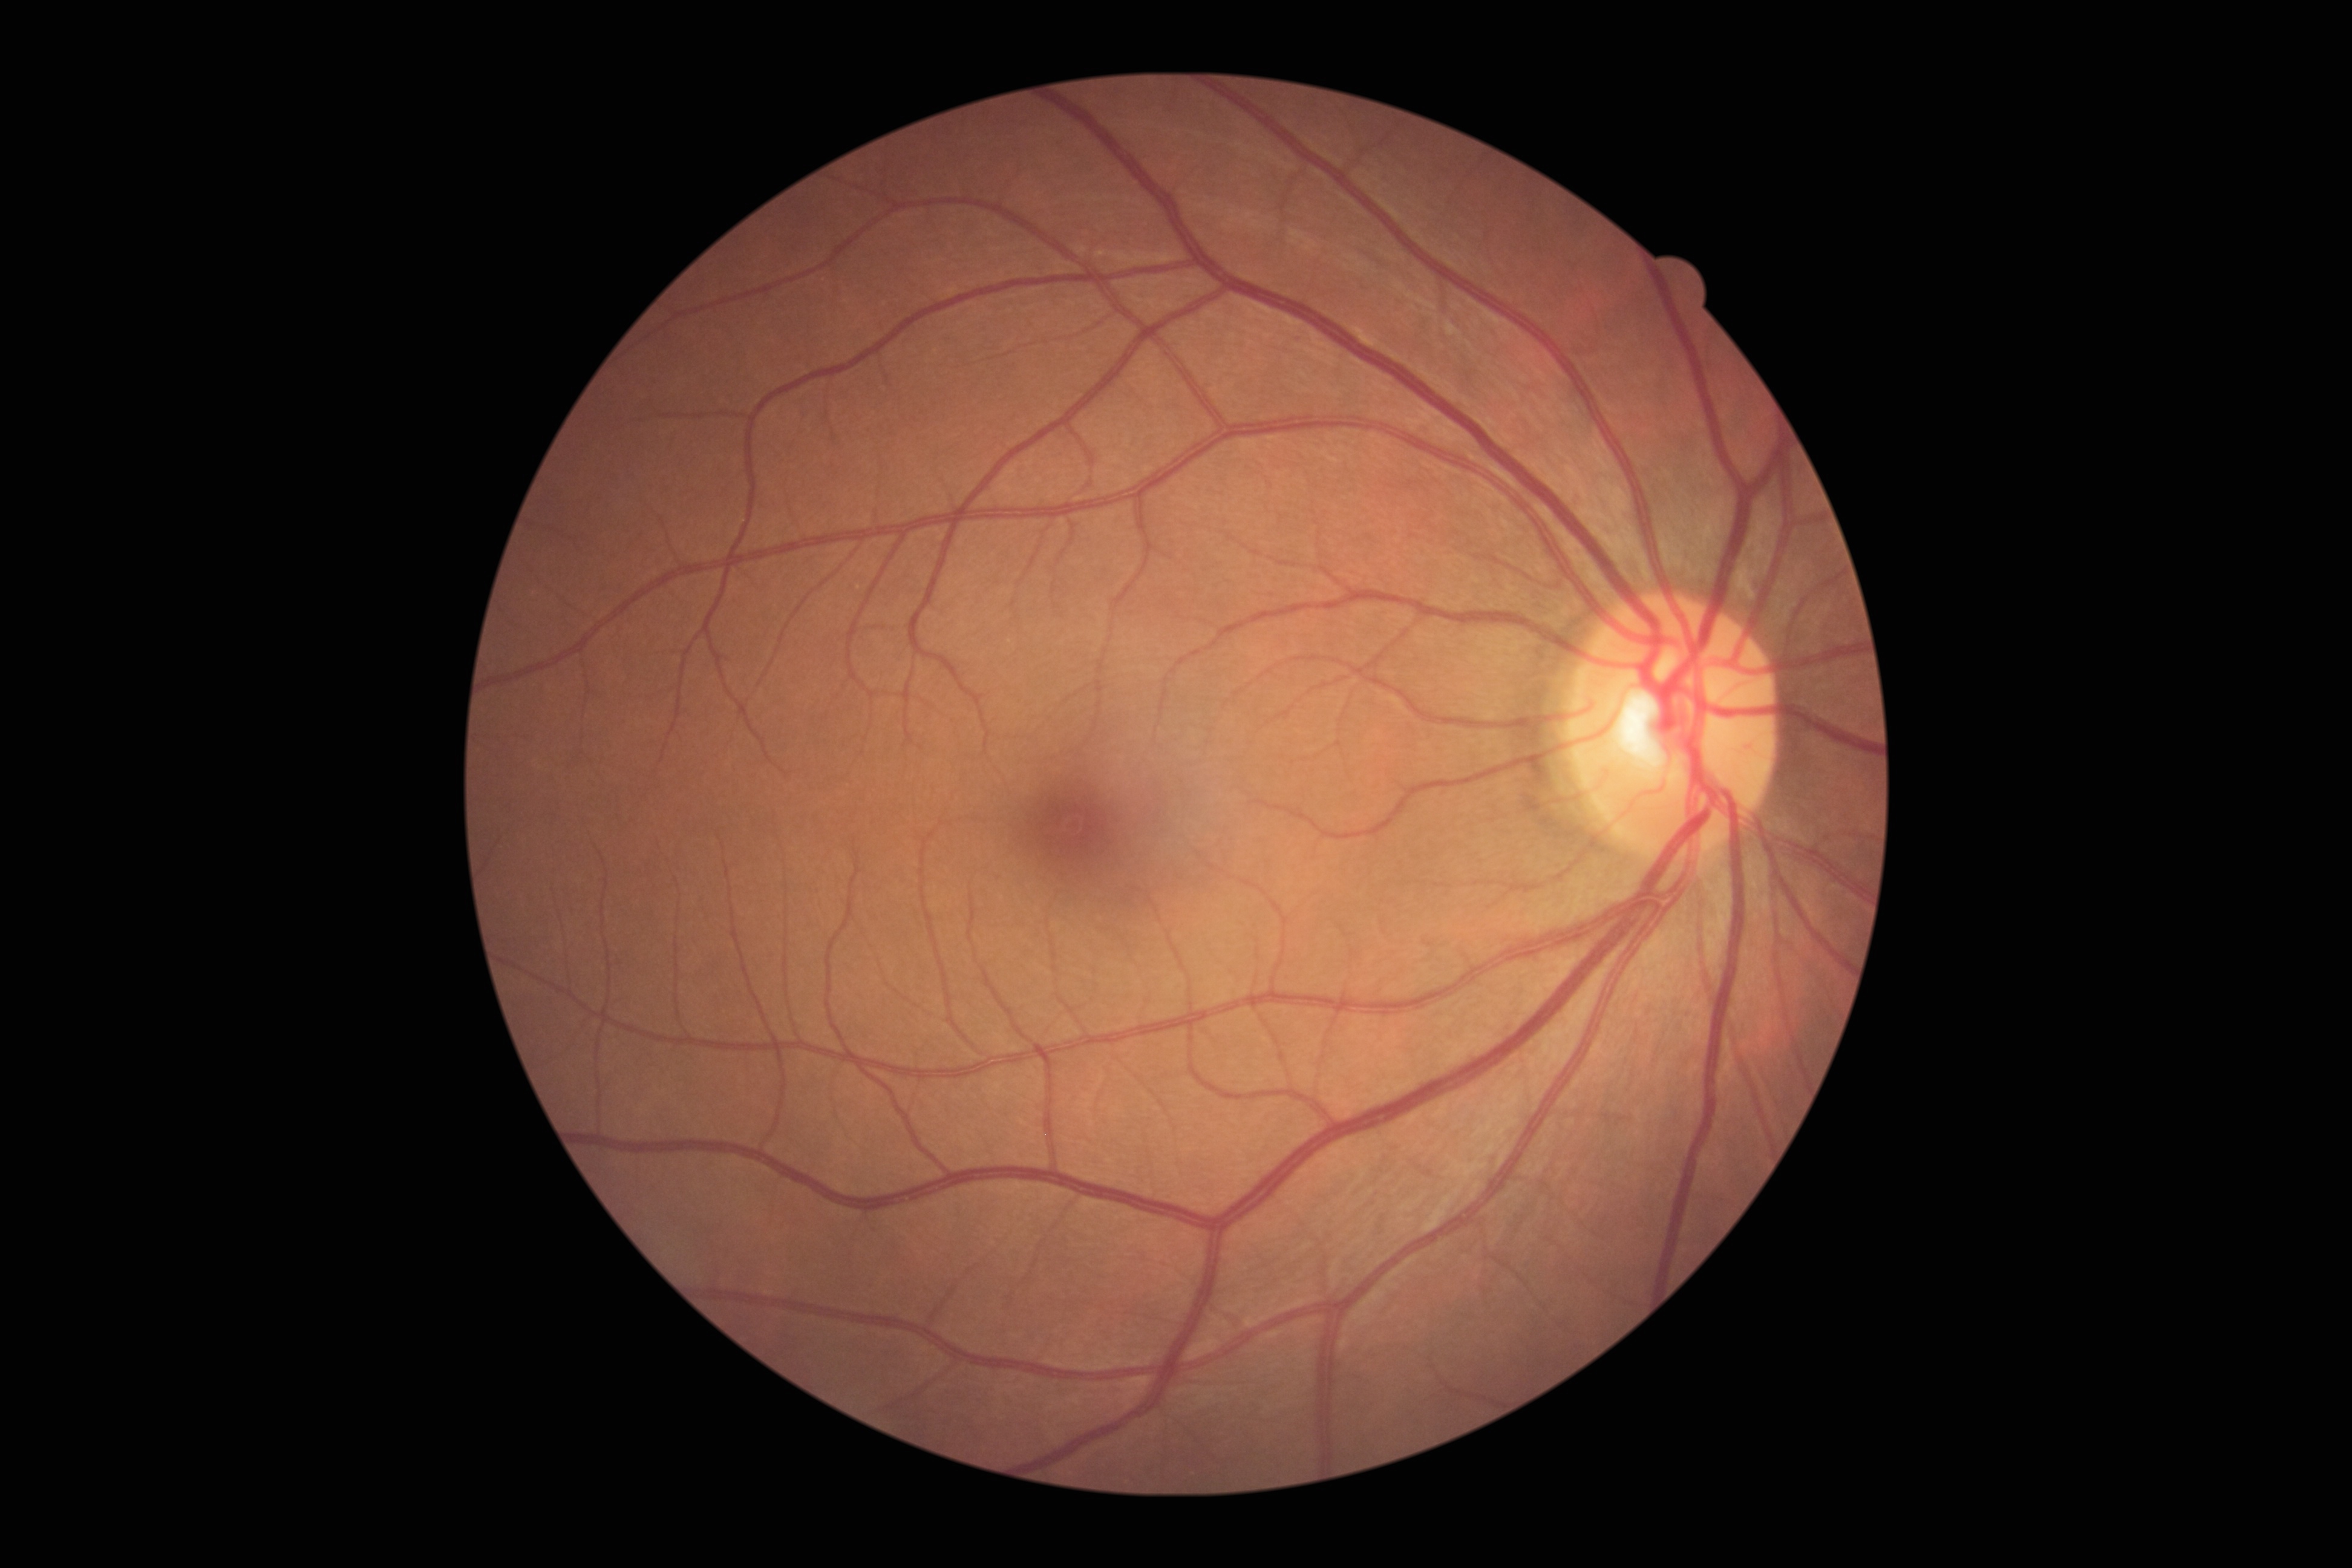
DR stage: grade 0.